Diabetic retinopathy graded by the modified Davis classification: 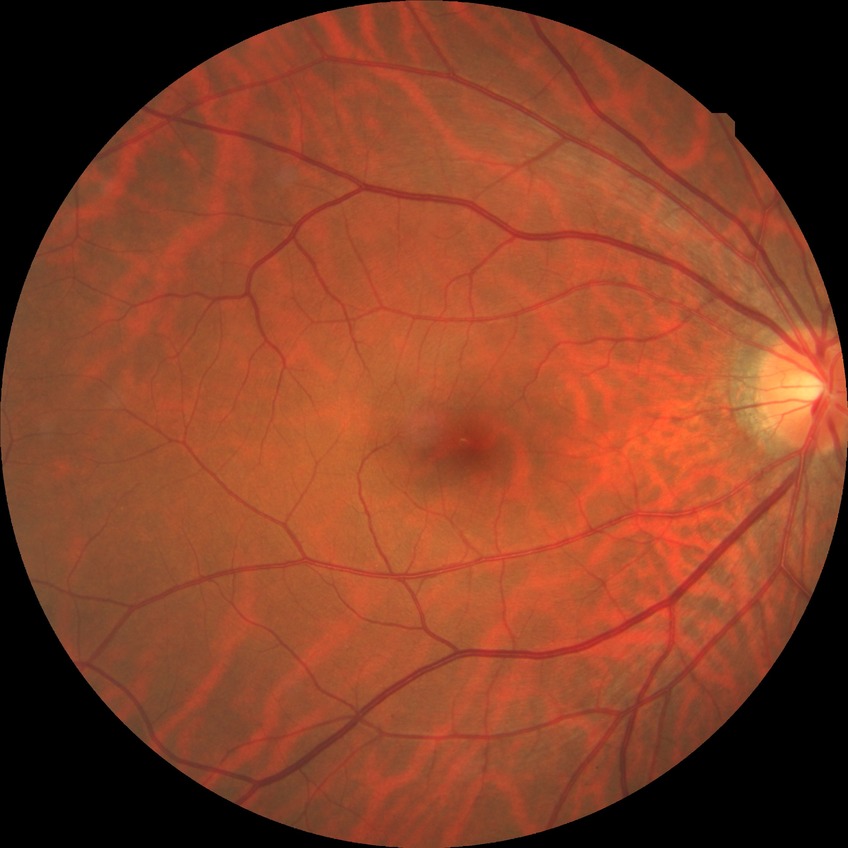 Annotations:
* modified Davis classification: no diabetic retinopathy